Pediatric wide-field fundus photograph. 1240 x 1240 pixels:
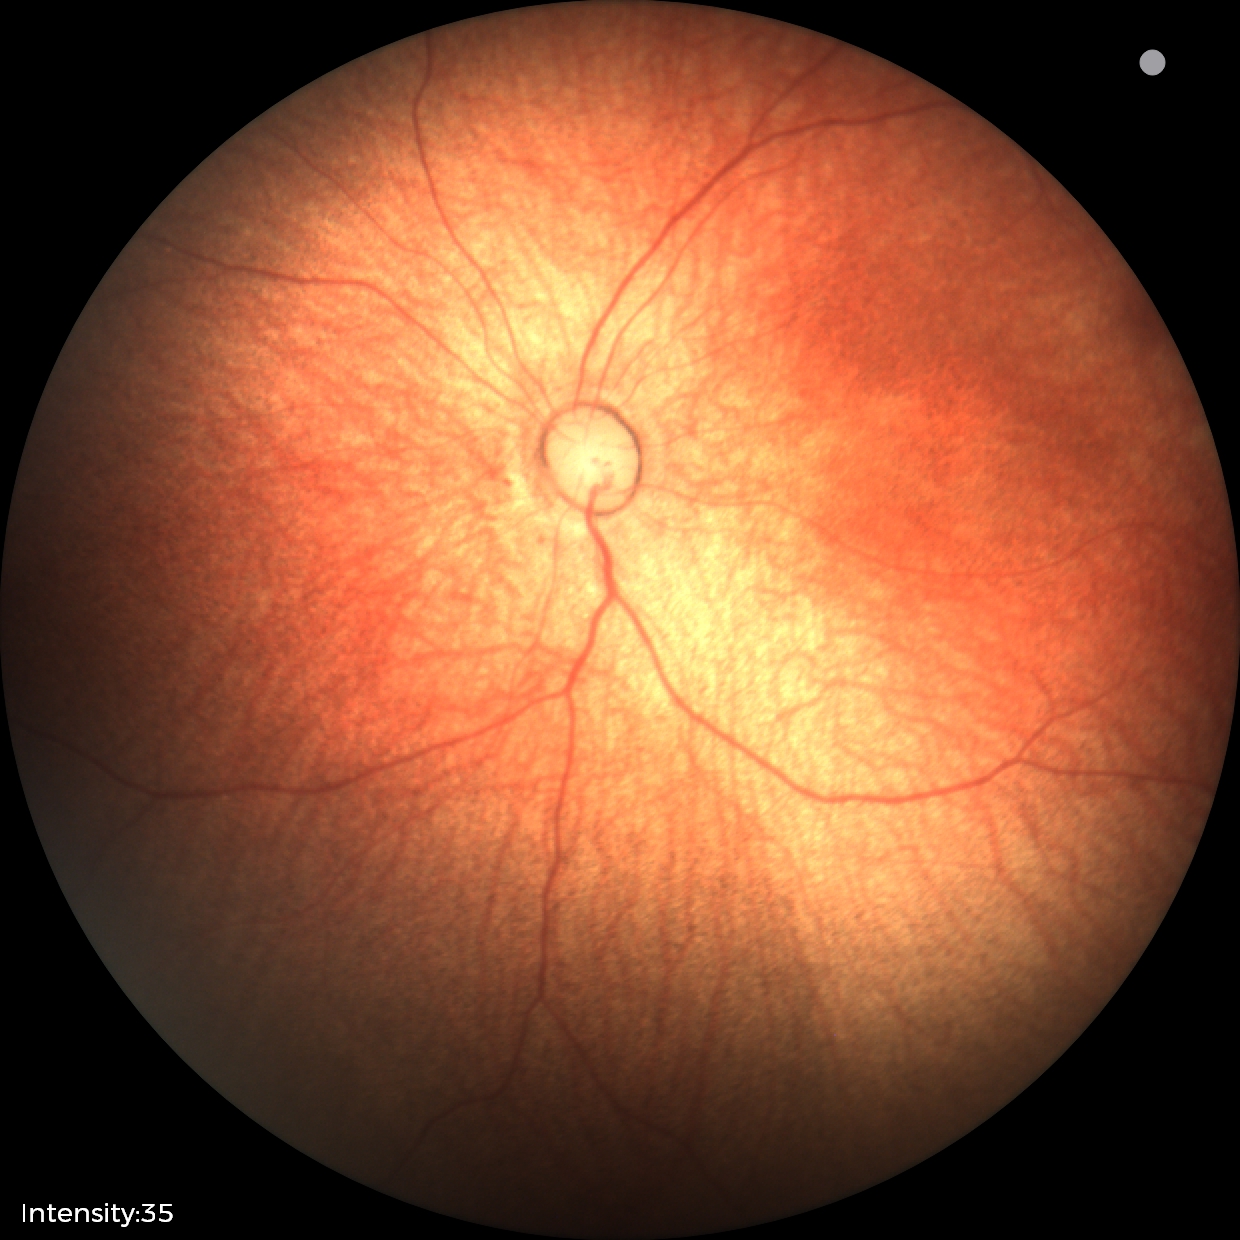
Normal screening examination.